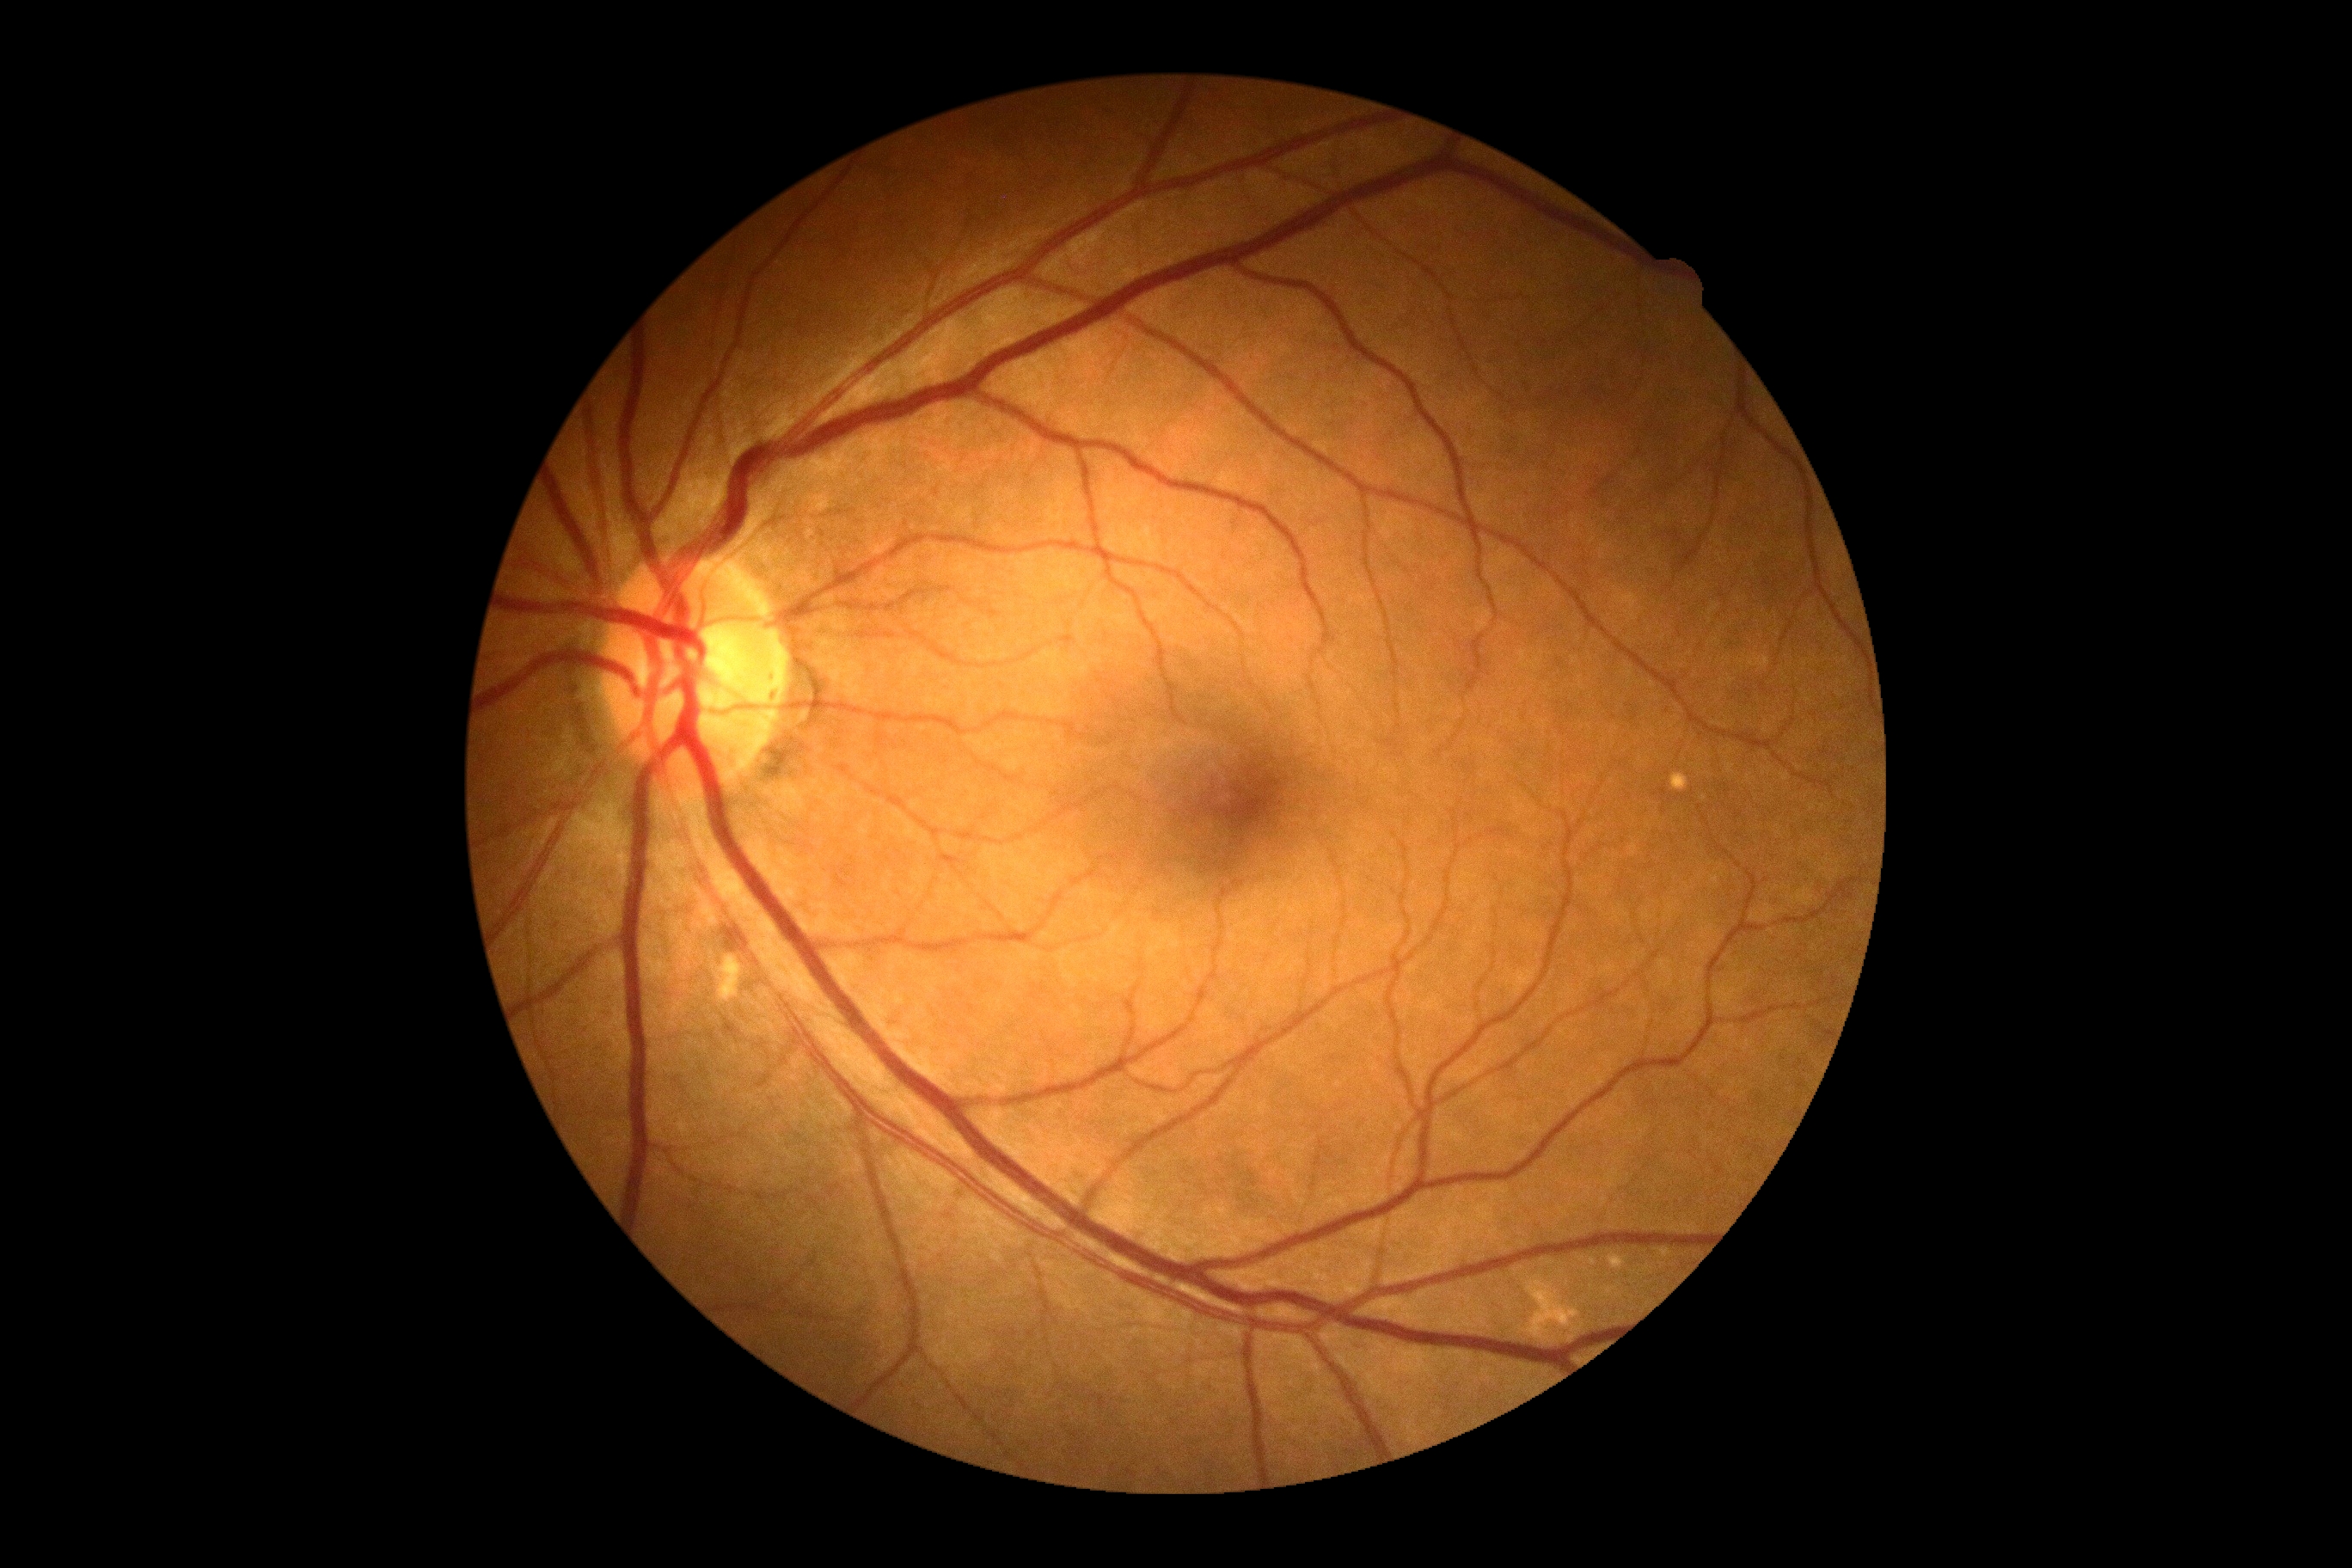

  dr_impression: no signs of DR
  dr_grade: 0